634x634px, fundus photograph cropped around the optic nerve head, mydriatic acquisition
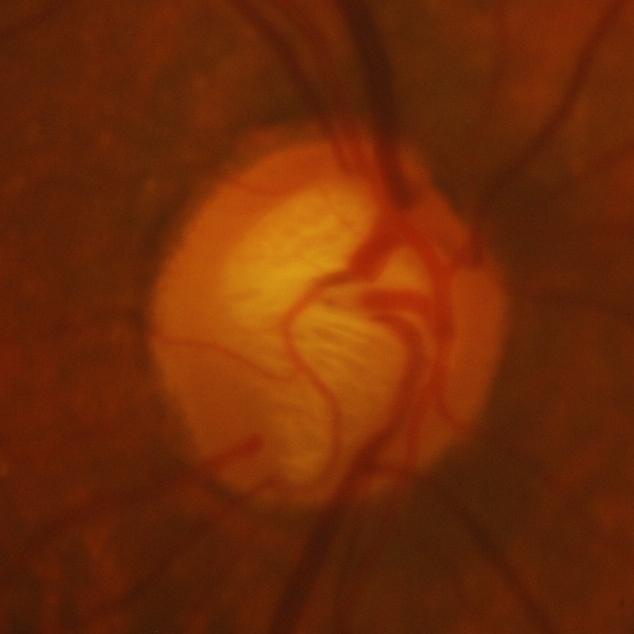
The image shows evidence of glaucoma.